Retinal fundus photograph · 45° field of view · NIDEK AFC-230 · 848 by 848 pixels
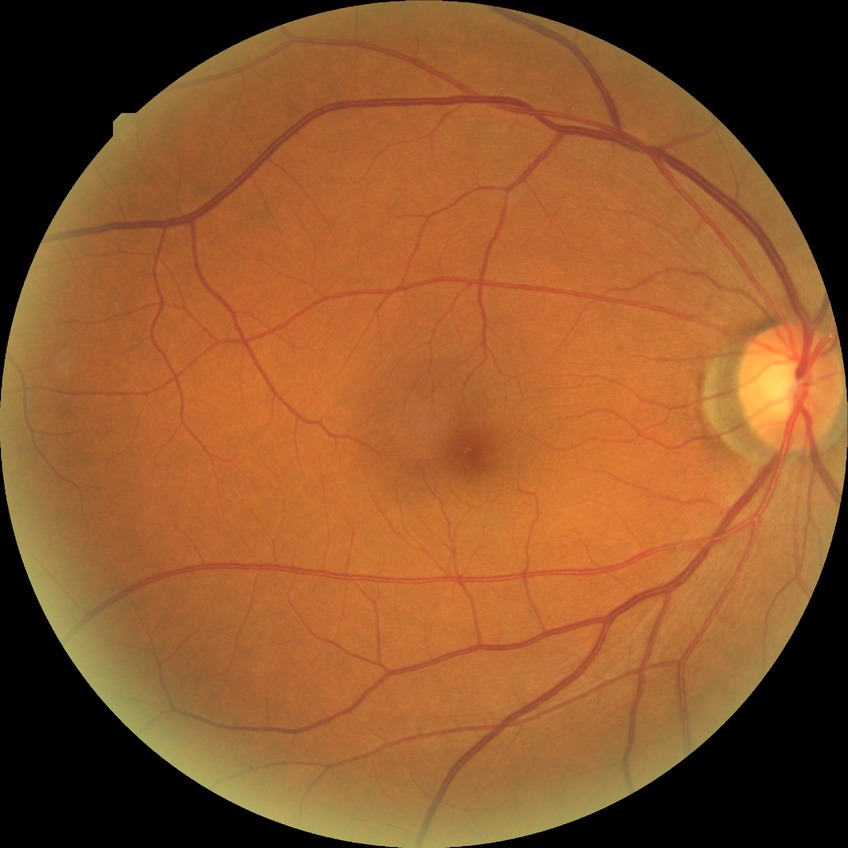

retinopathy stage@no diabetic retinopathy.